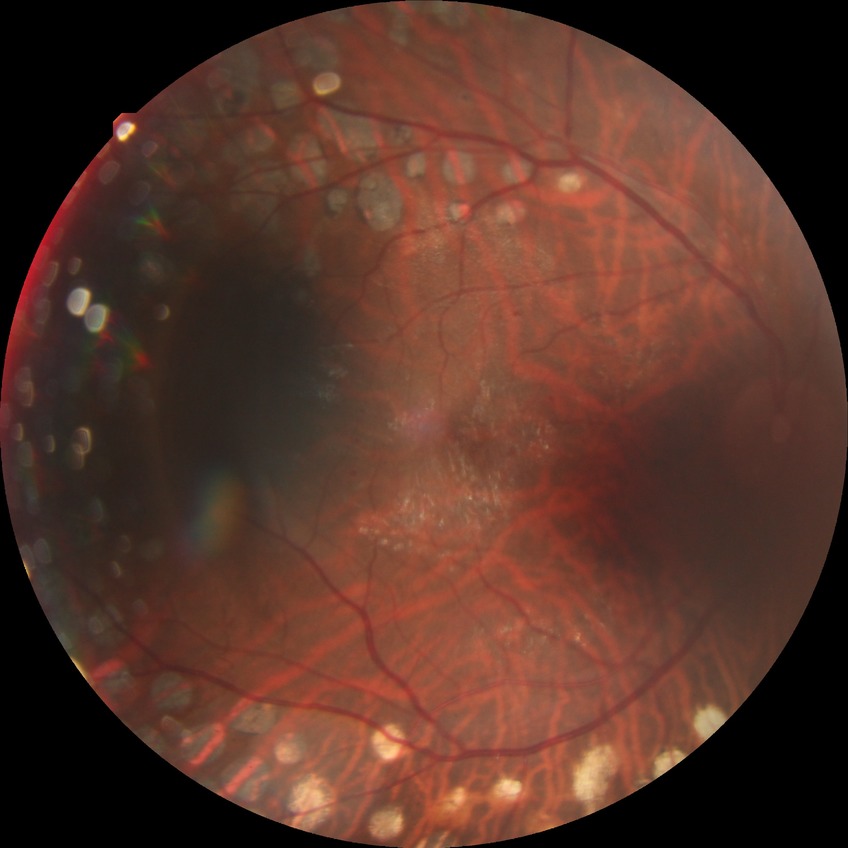

modified Davis classification = proliferative diabetic retinopathy.